Camera: NIDEK AFC-230. 848 by 848 pixels
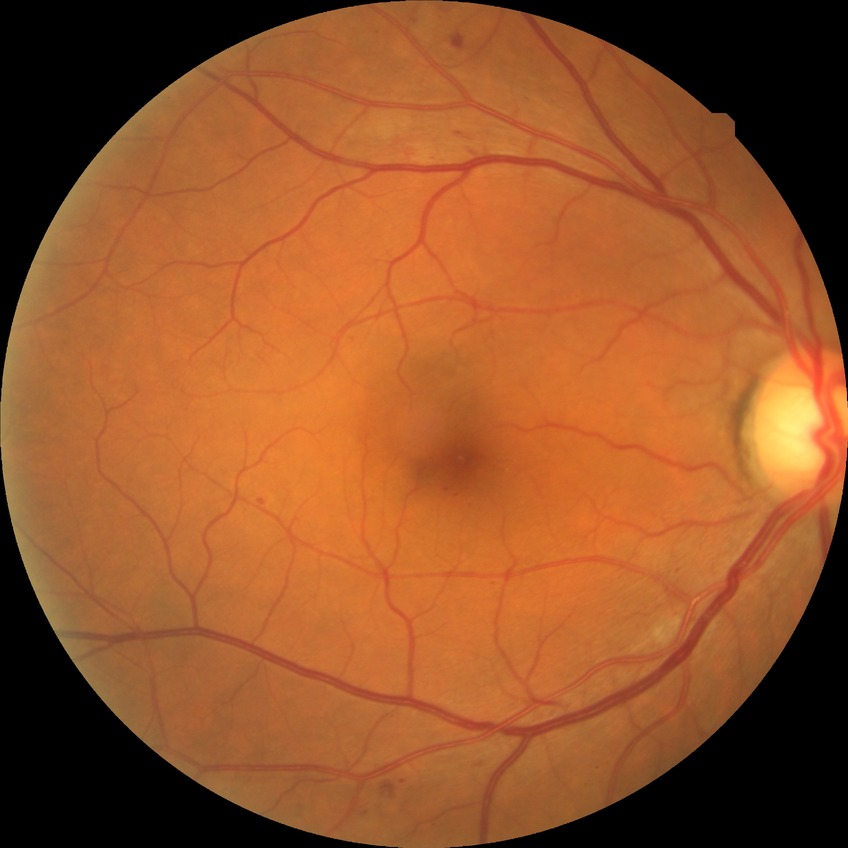

DR grade is SDR.